Pediatric retinal photograph (wide-field); 640 x 480 pixels.
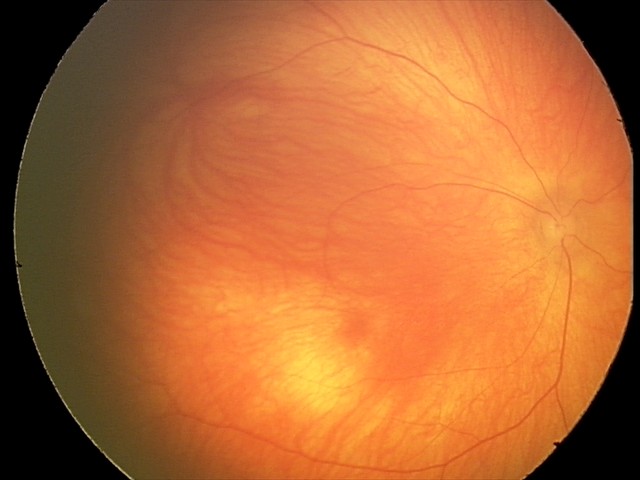
Screening examination diagnosed as physiological.